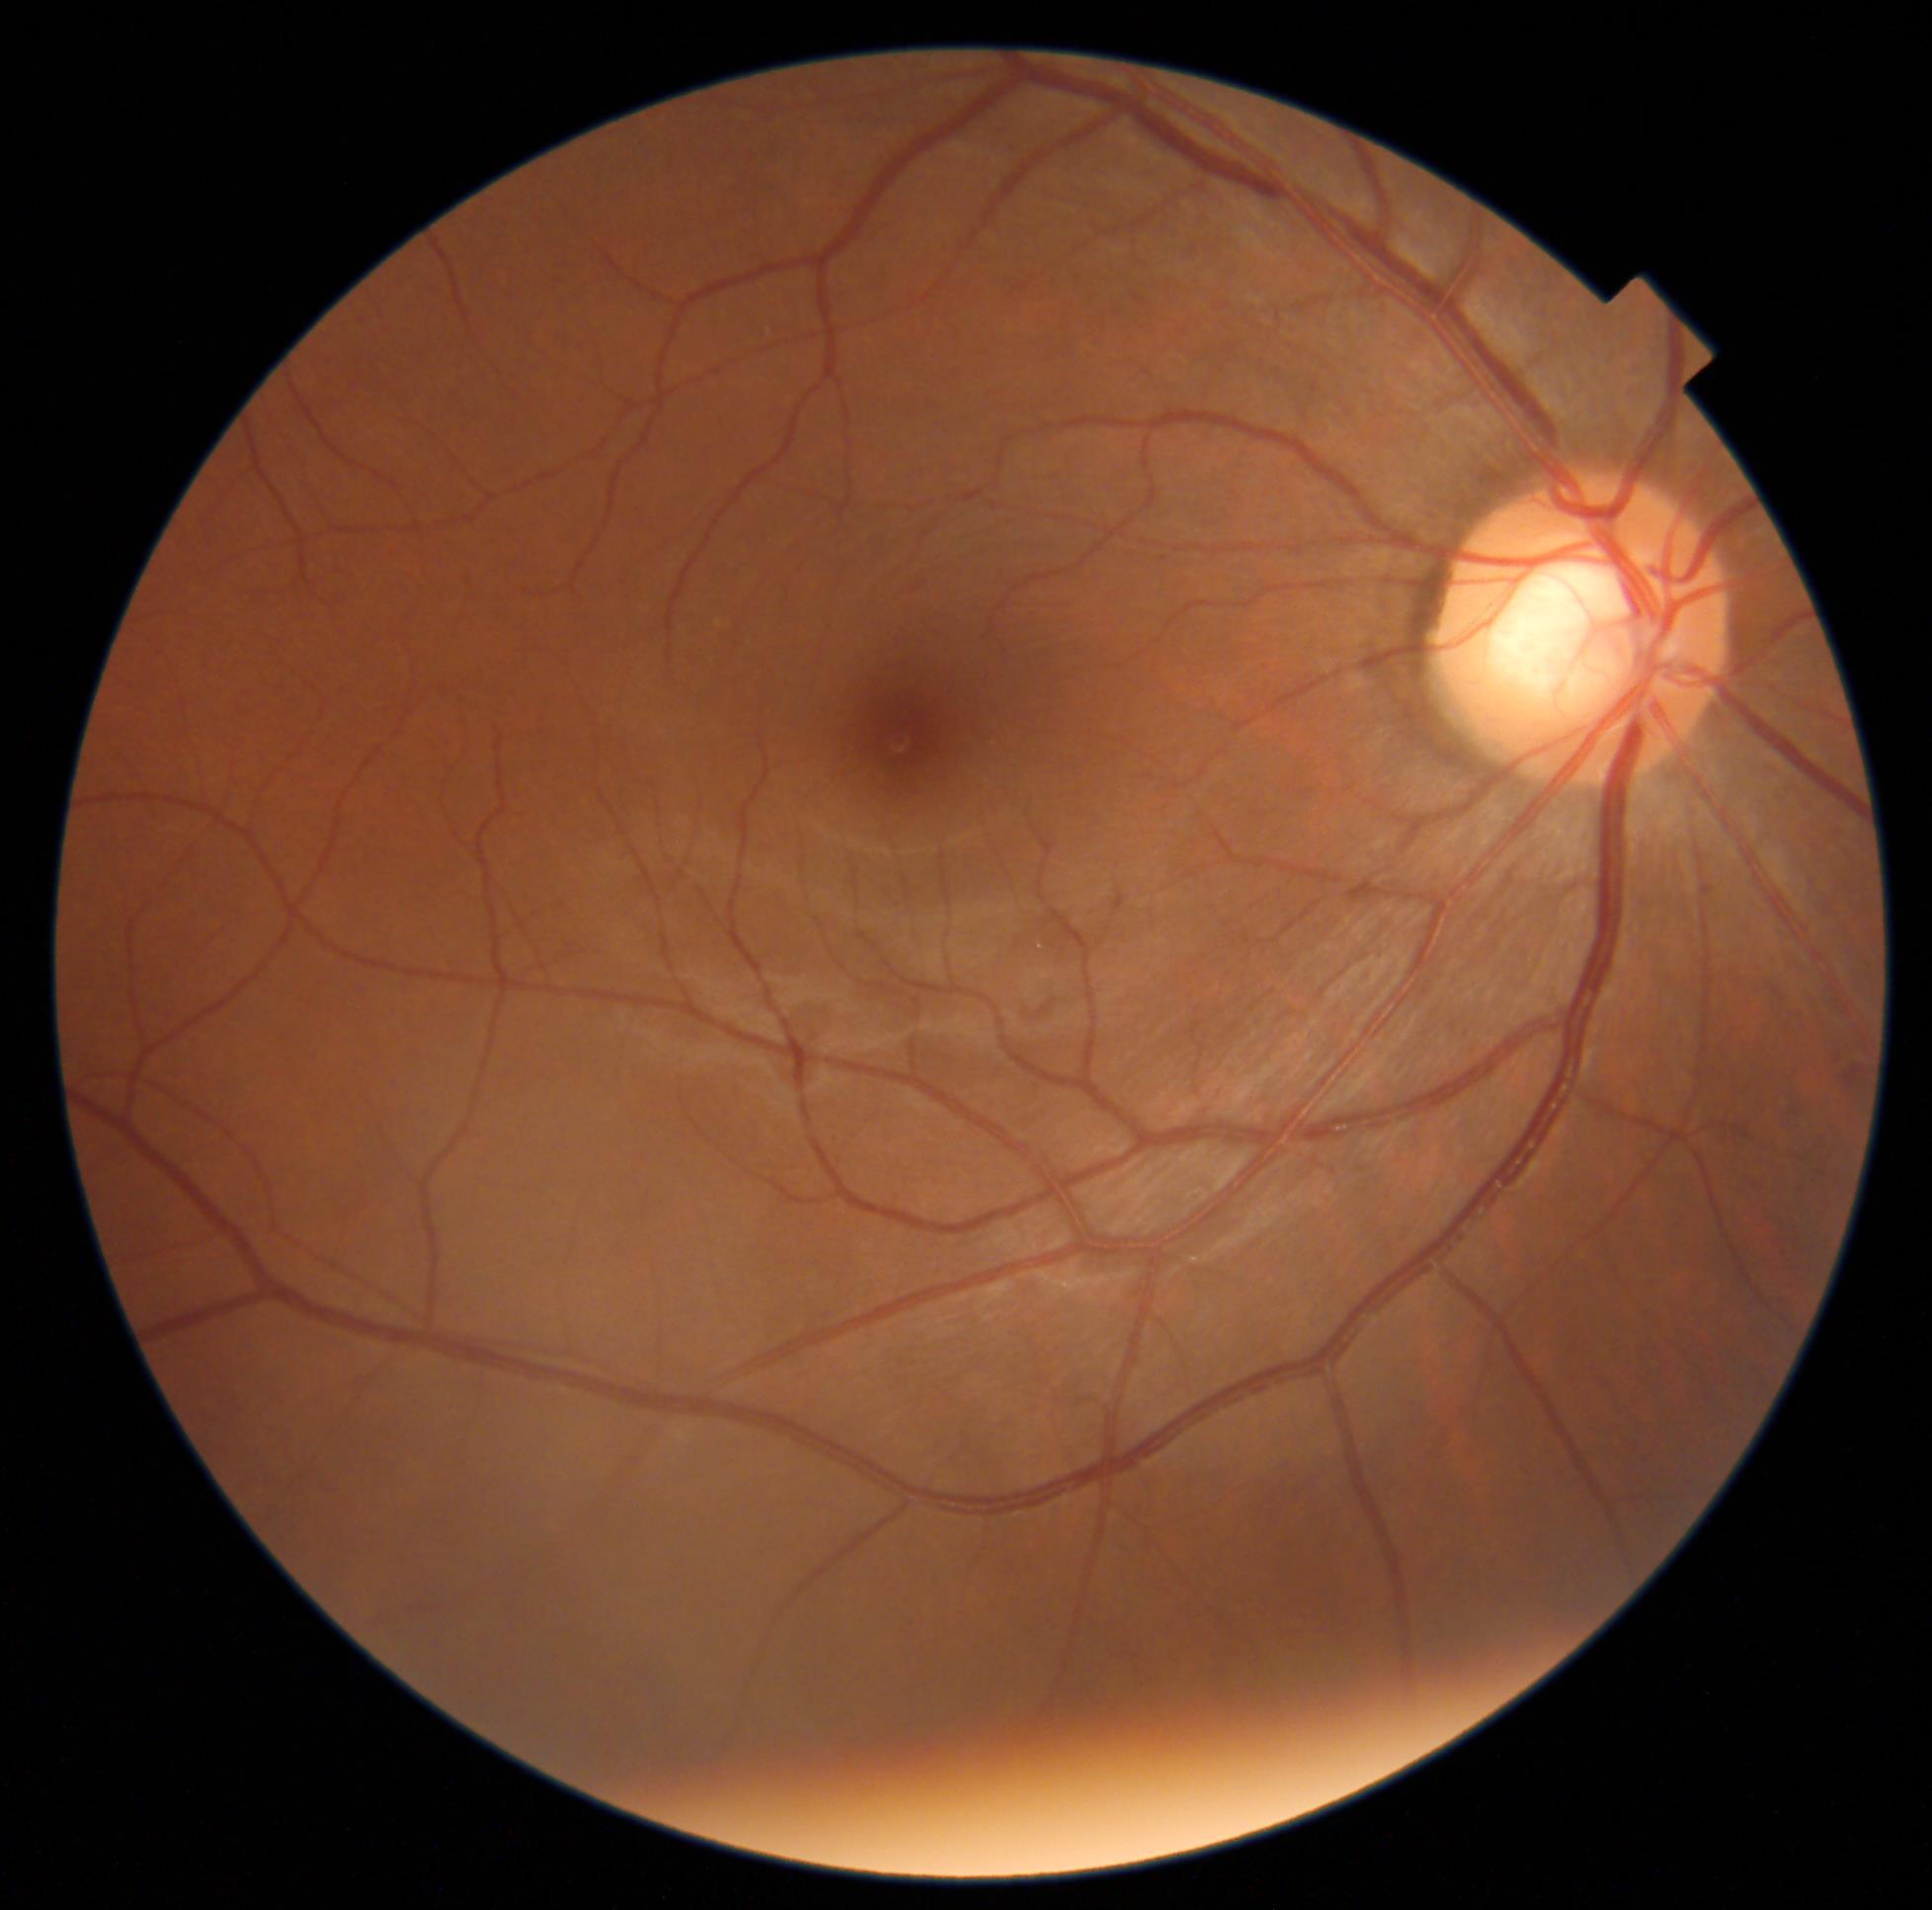 DR impression: no DR findings; diabetic retinopathy (DR): grade 0.